45-degree field of view, fundus photo, Davis DR grading, camera: NIDEK AFC-230, 848x848
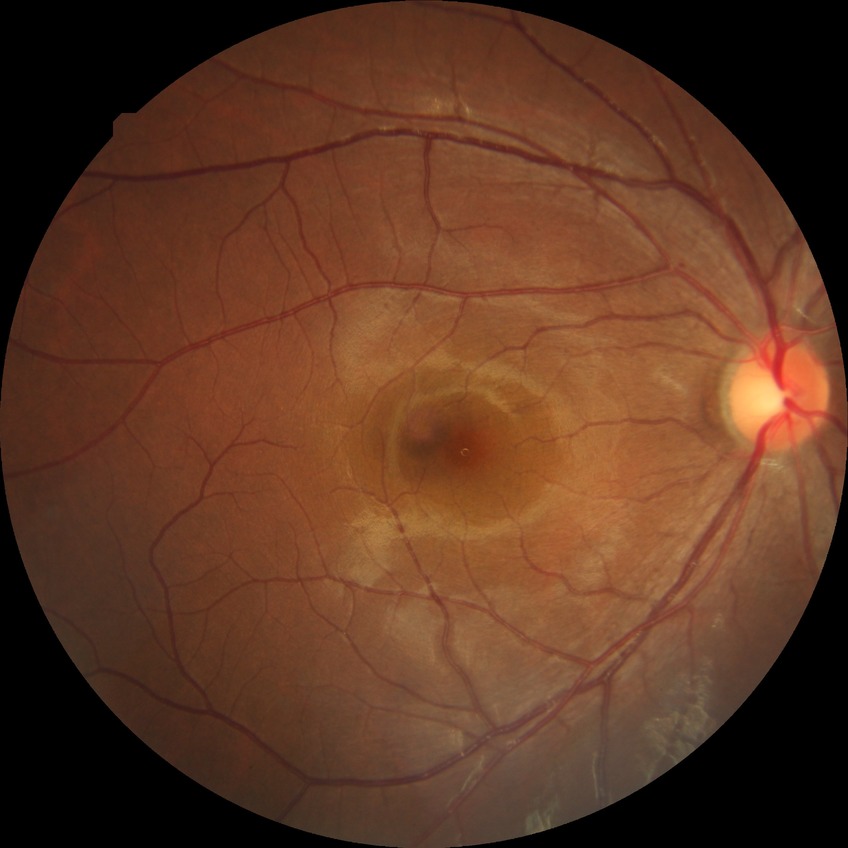

DR severity: SDR.